Wide-field fundus photograph of an infant:
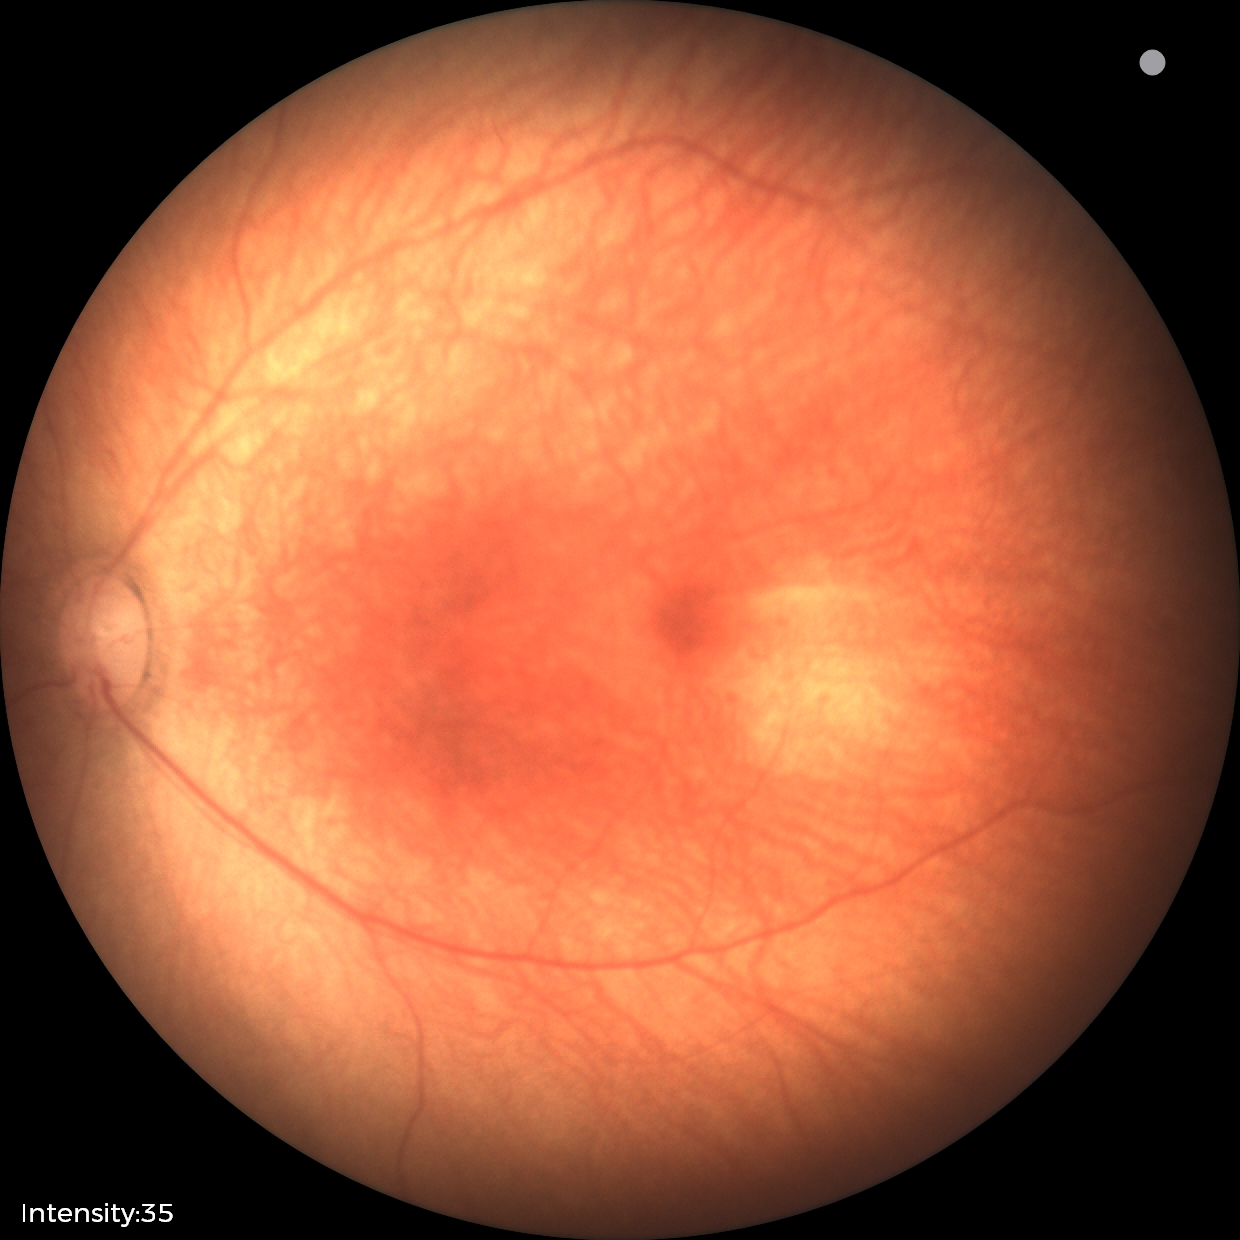
Normal screening examination.